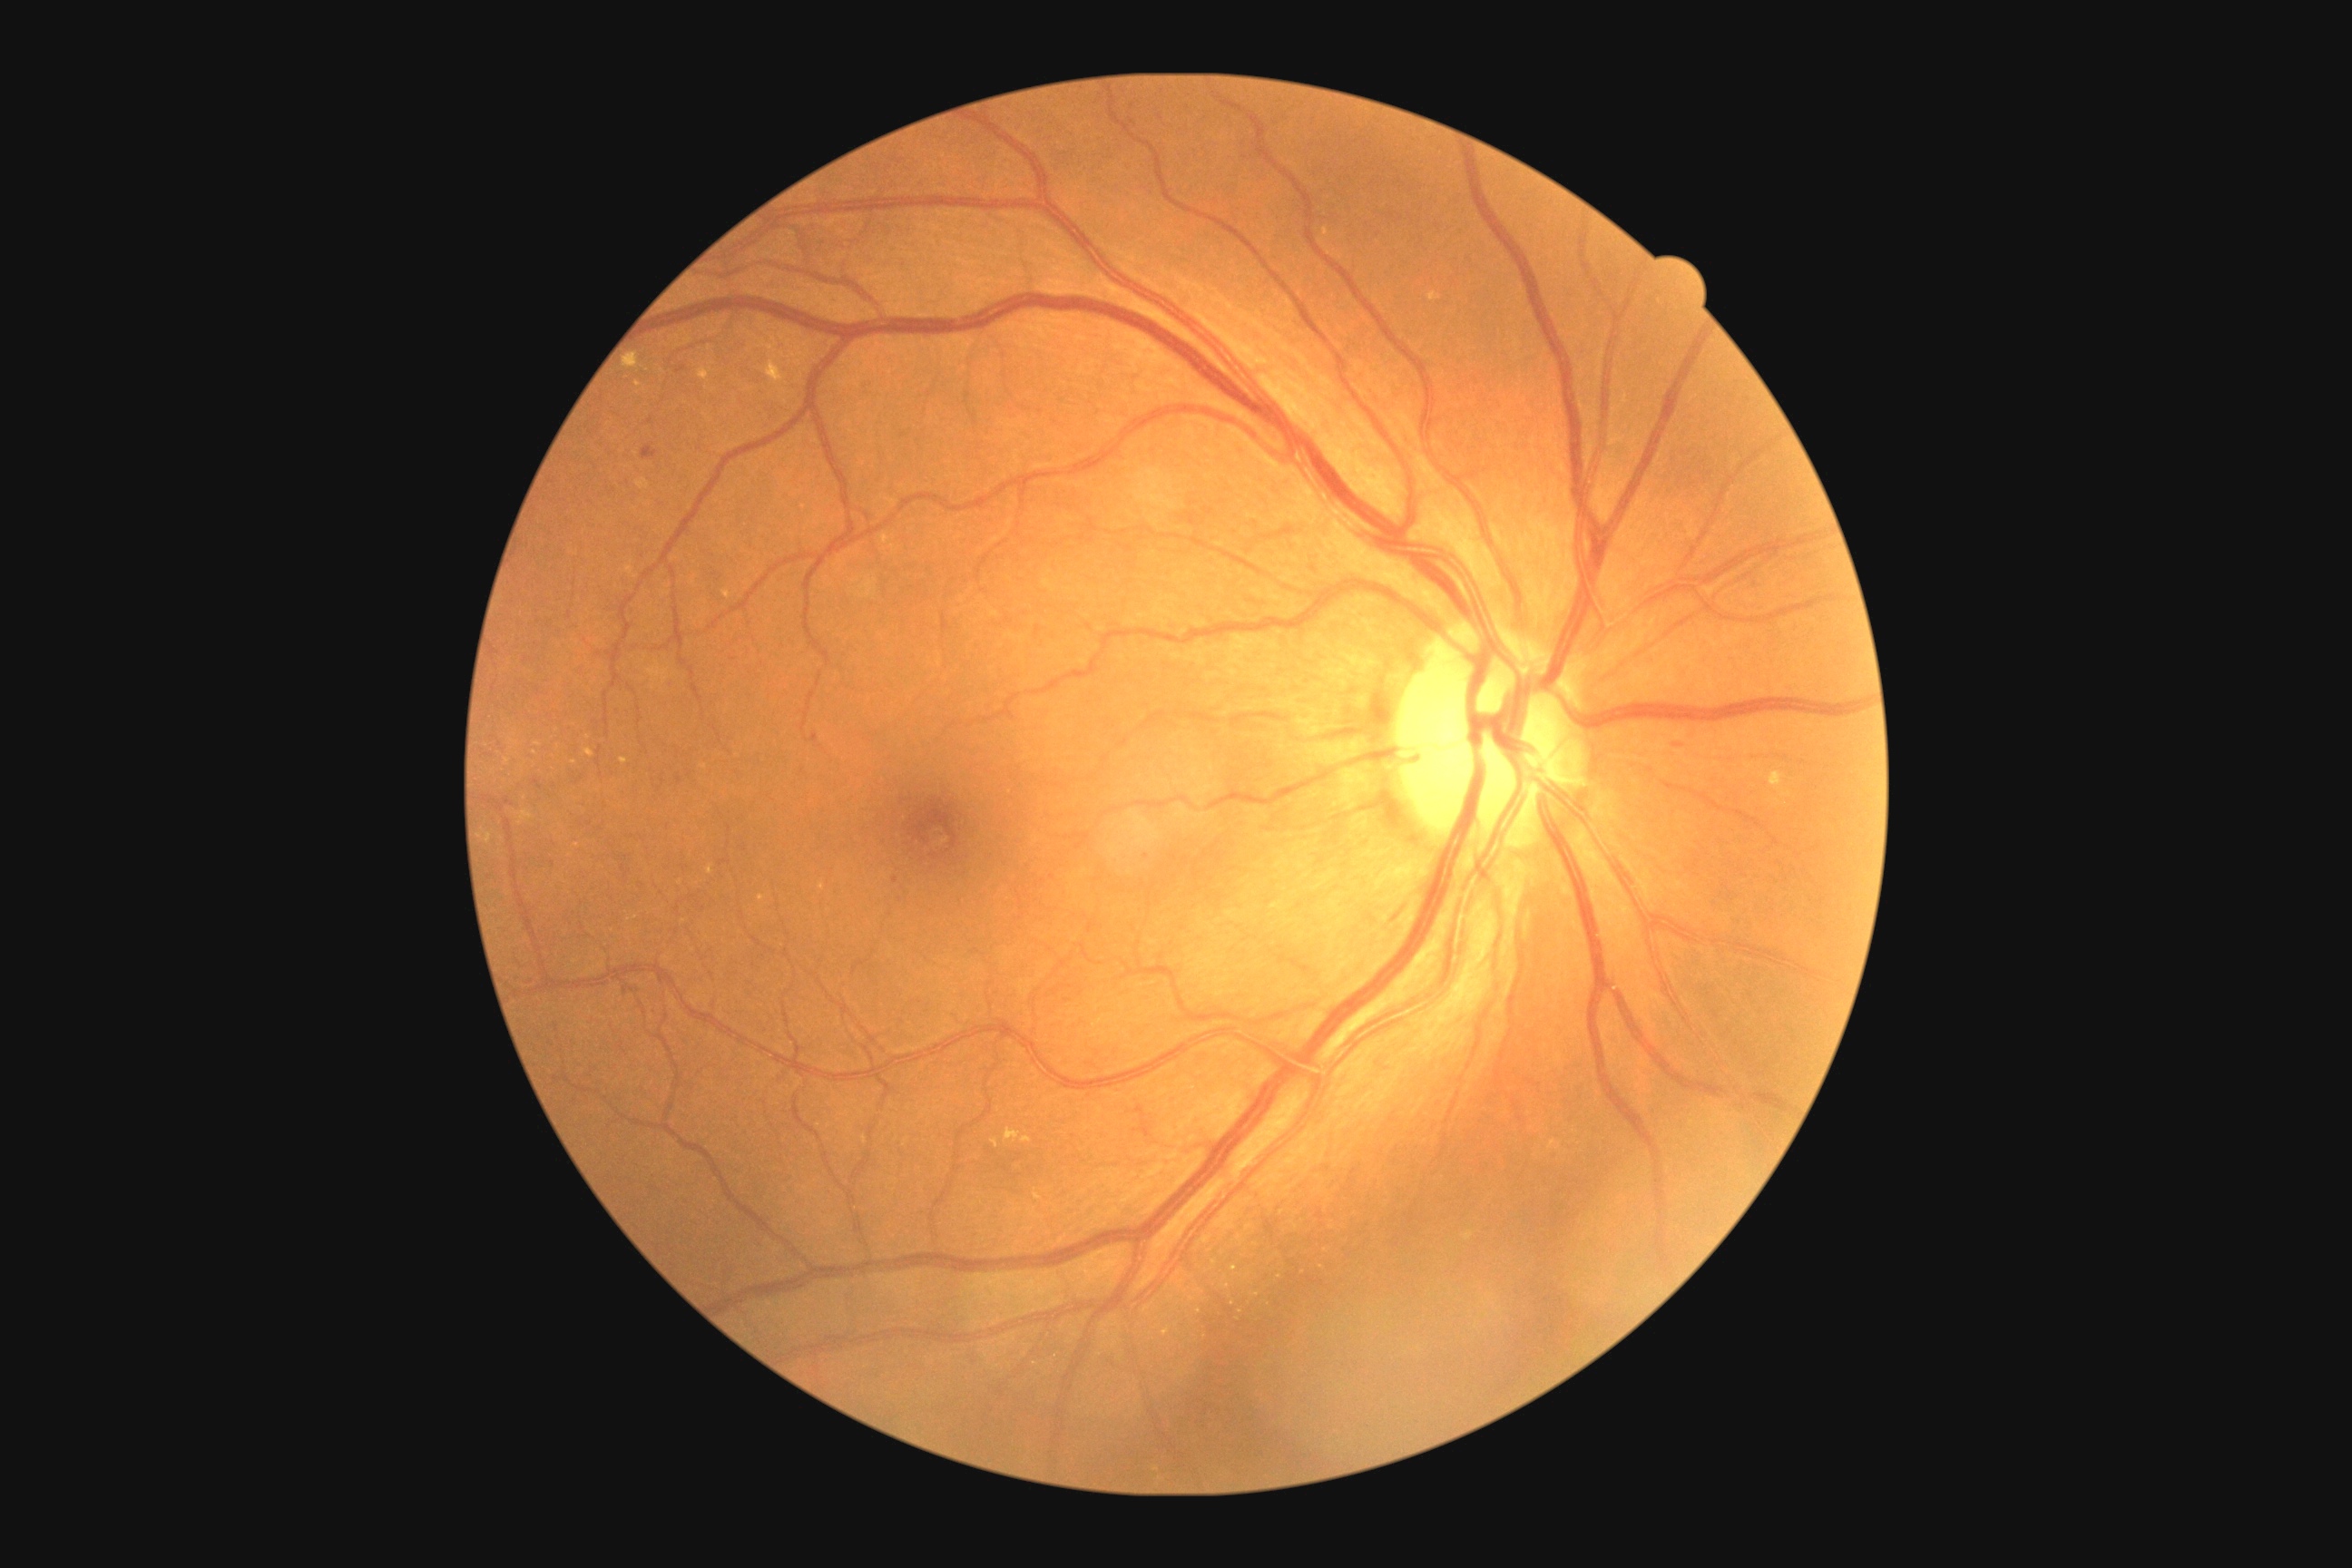

Diabetic retinopathy severity is 2
Representative lesions:
hard exudates (partial): [992,1139,999,1148]; [518,810,534,825]; [485,834,493,843]; [583,749,594,758]; [534,741,542,747]; [698,368,712,382]; [623,351,640,369]
Smaller hard exudates around 507, 762; 573, 762; 639, 384; 761, 899; 512, 741